Image size 848x848: 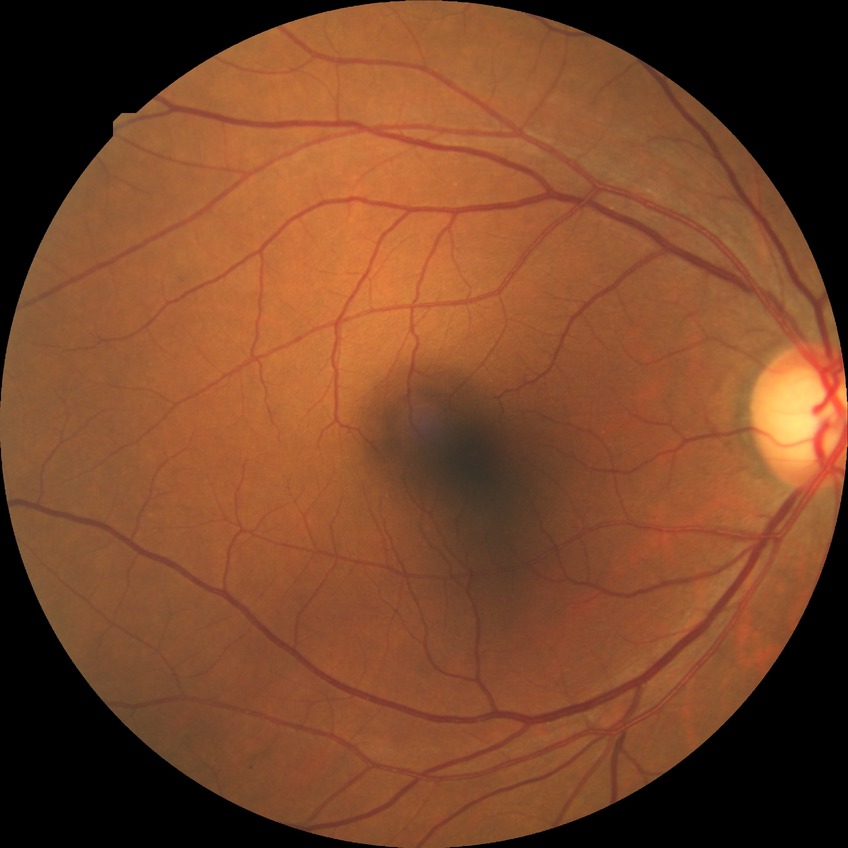 Annotations:
- diabetic retinopathy (DR): SDR (simple diabetic retinopathy)